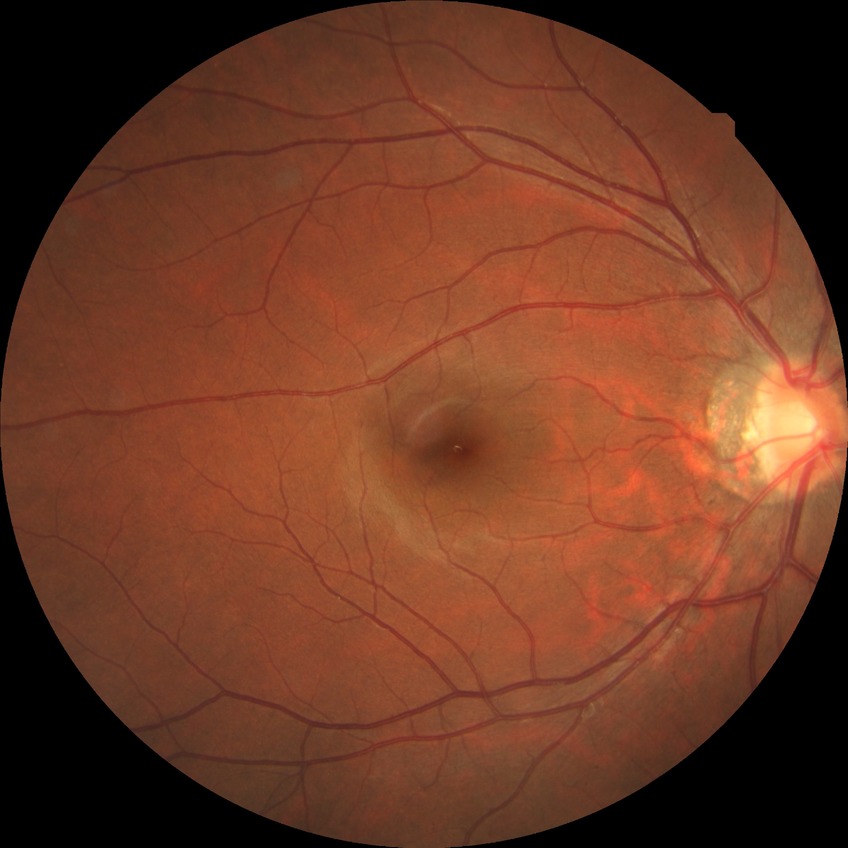
diabetic retinopathy (DR): no diabetic retinopathy (NDR).